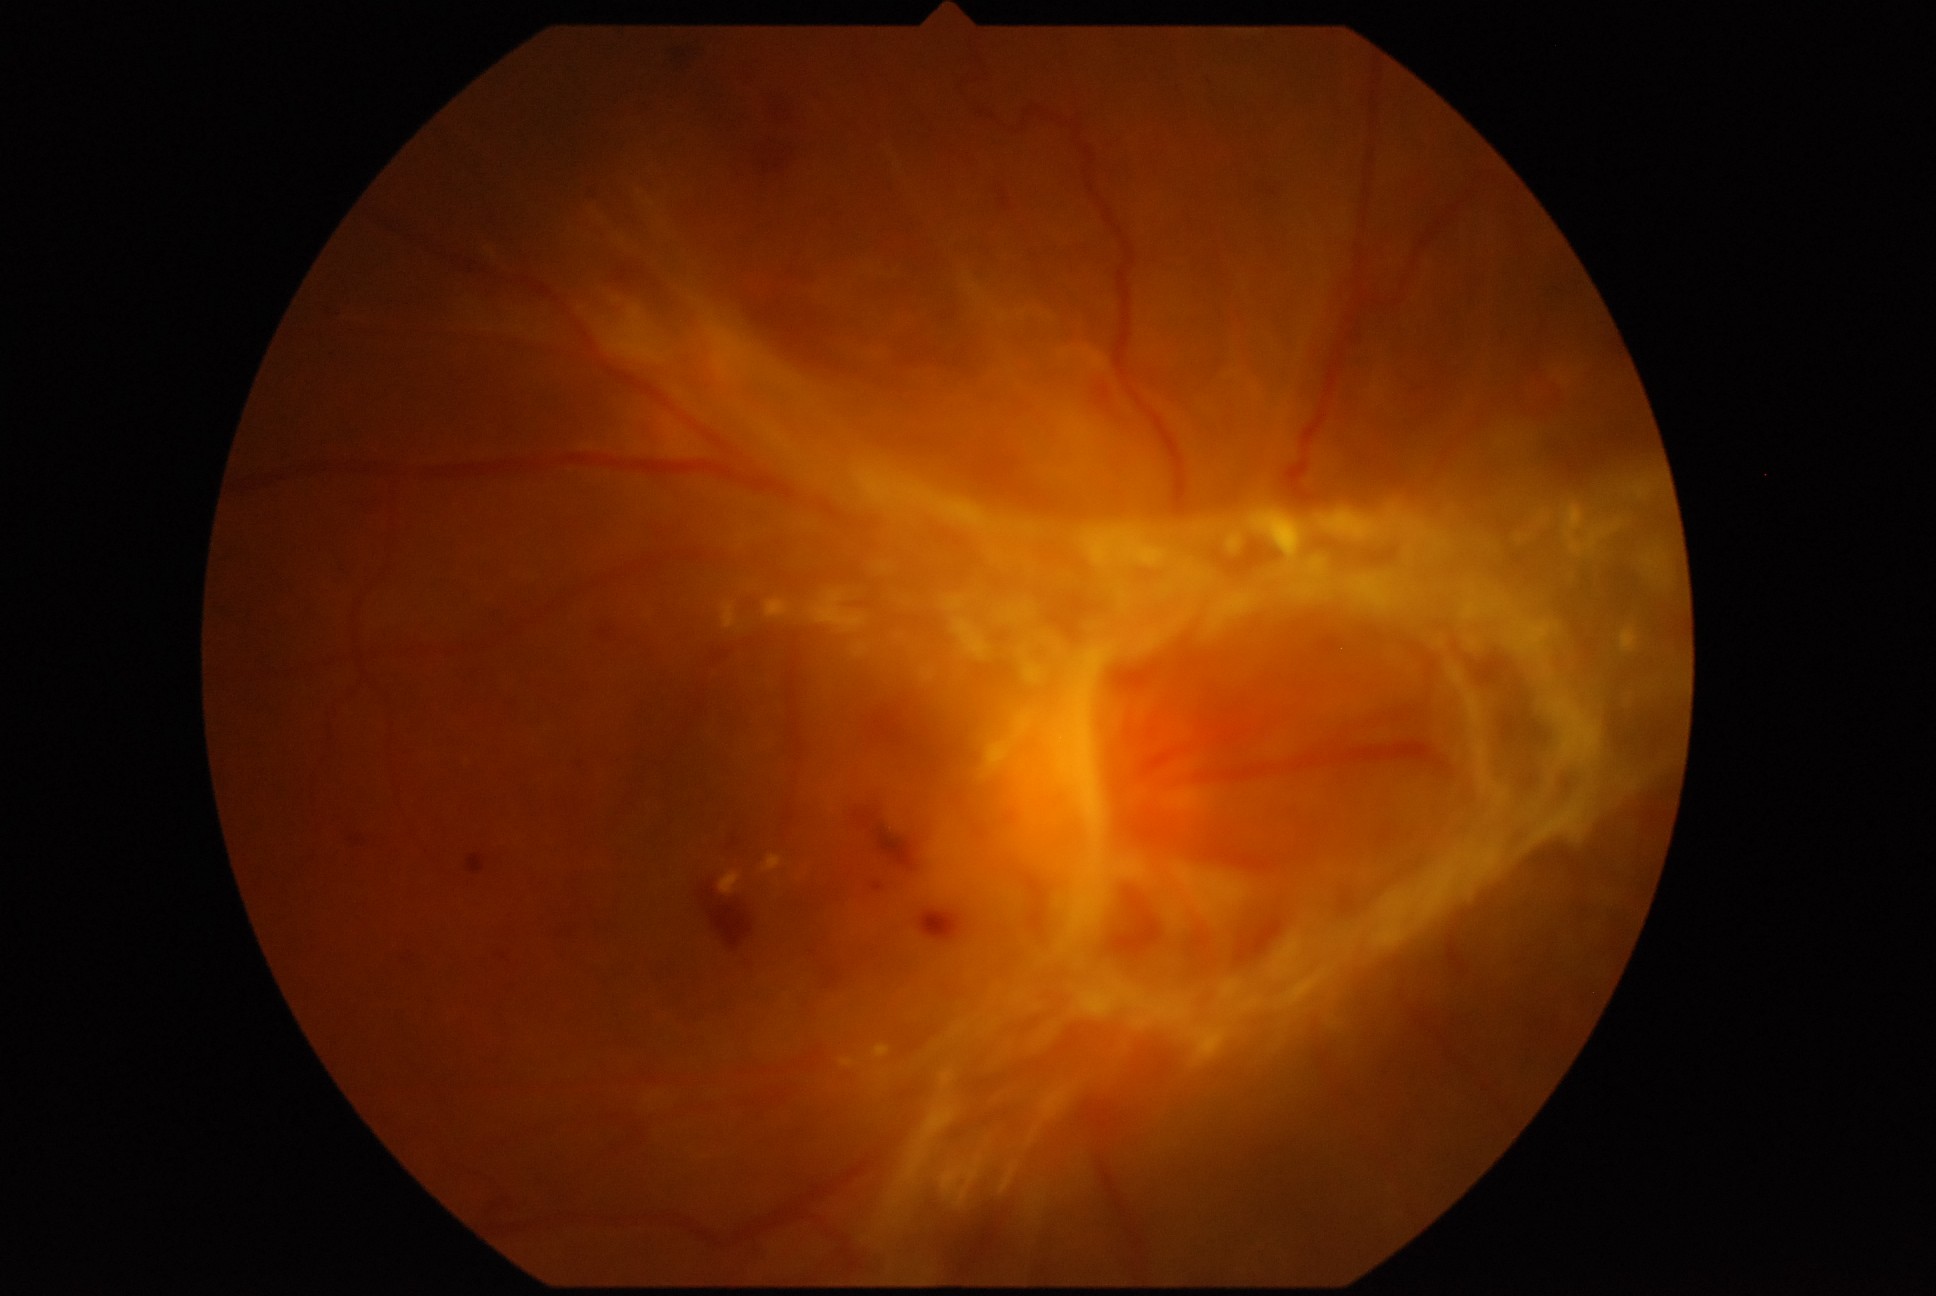 Retinopathy: PDR (grade 4) — neovascularization and/or vitreous/pre-retinal hemorrhage.